Infant wide-field fundus photograph:
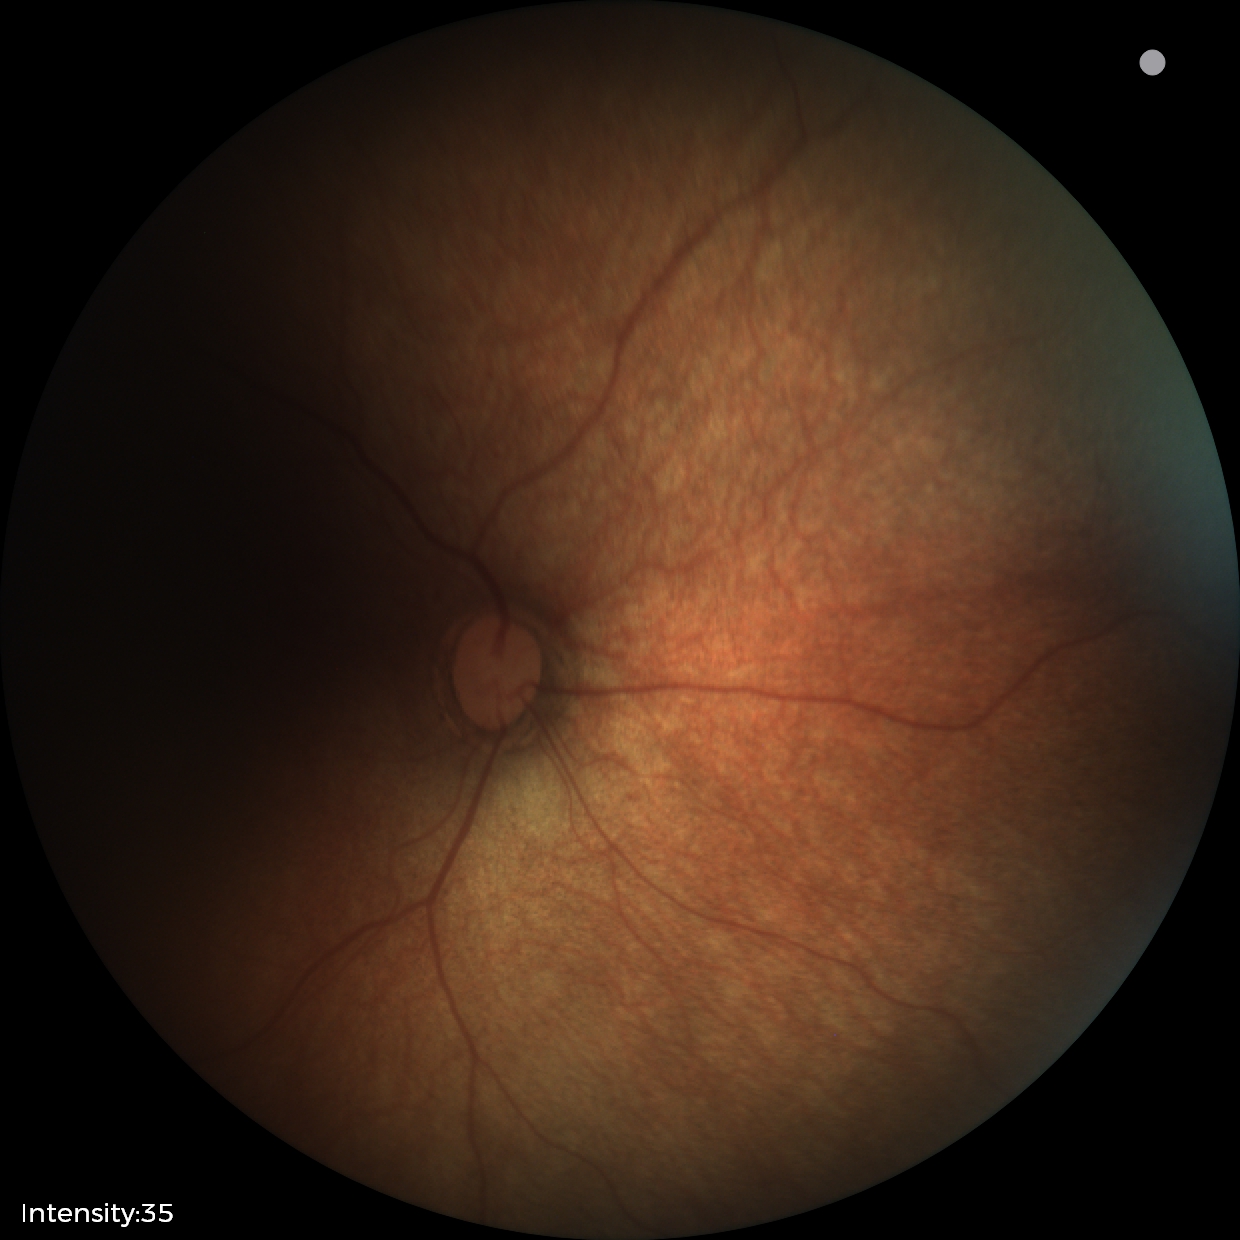 Examination with physiological retinal findings.